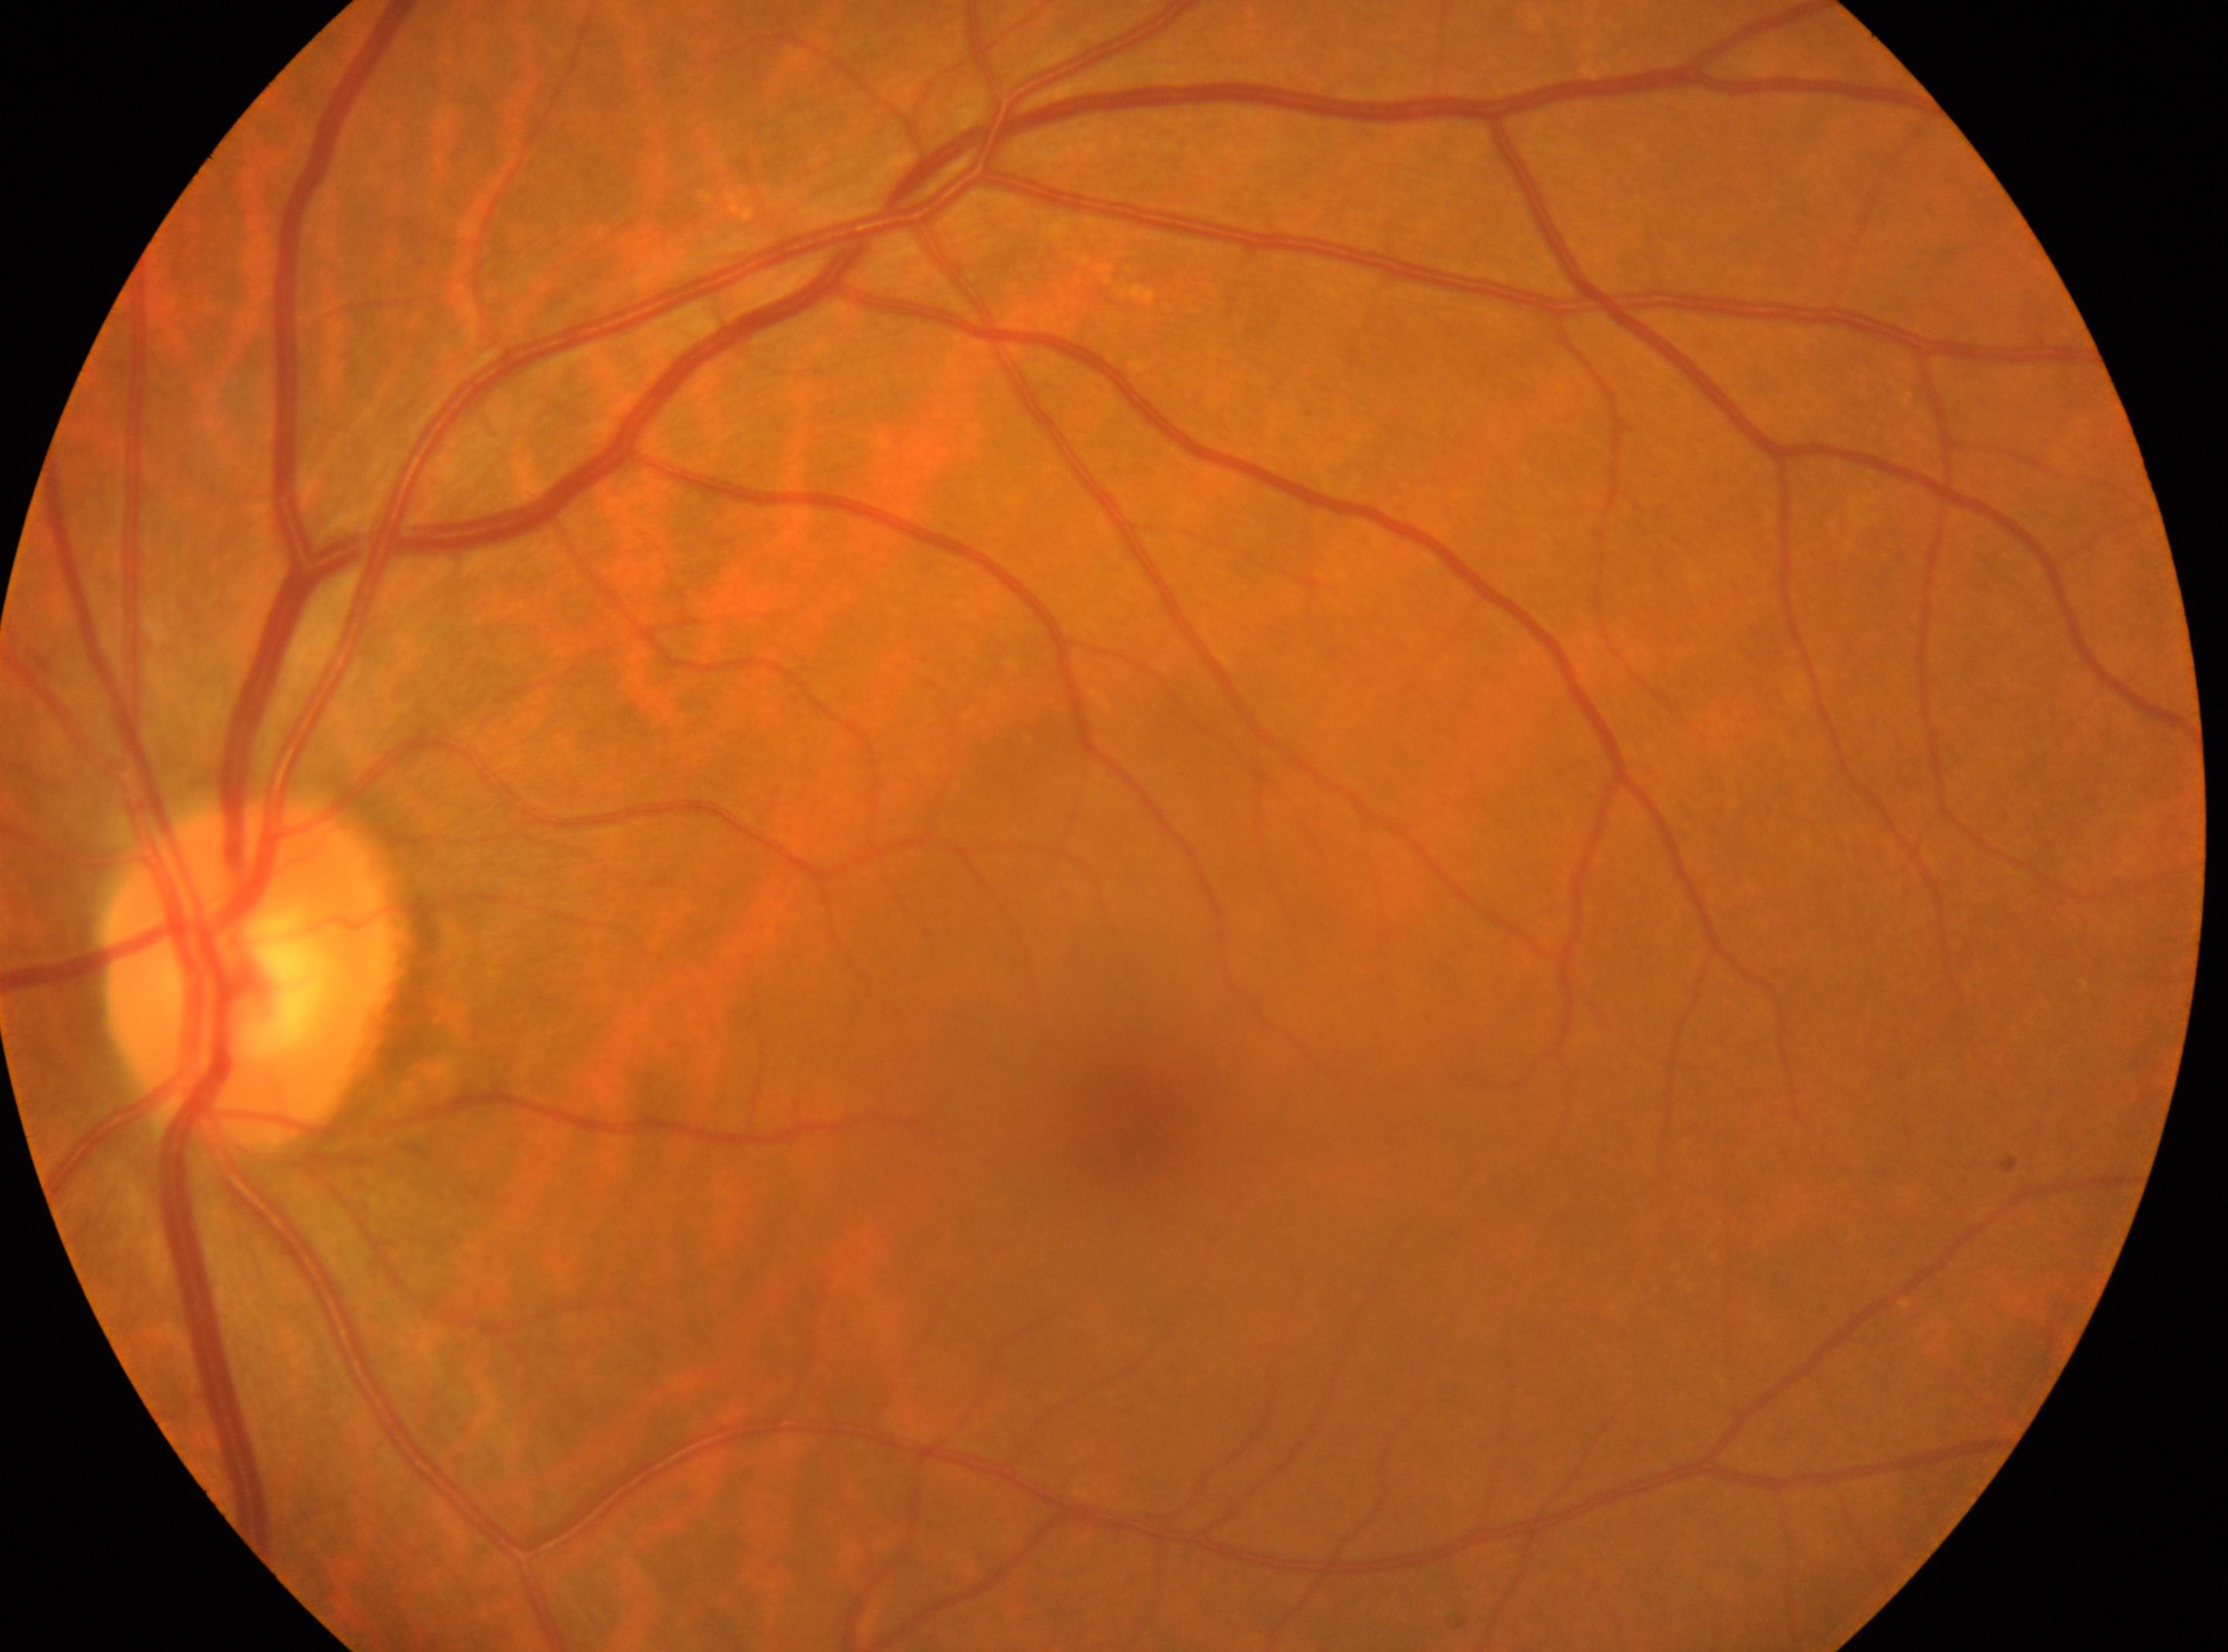

Eye: left.
The foveal center is at (1125,1123).
ONH: (252,974).
Diabetic retinopathy (DR): grade 0 (no apparent retinopathy).